Dilated pupil; disc-centered fundus crop — 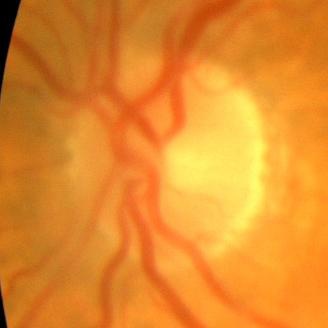
Optic disc appearance consistent with no glaucomatous findings.